CFP; 2212x1659px:
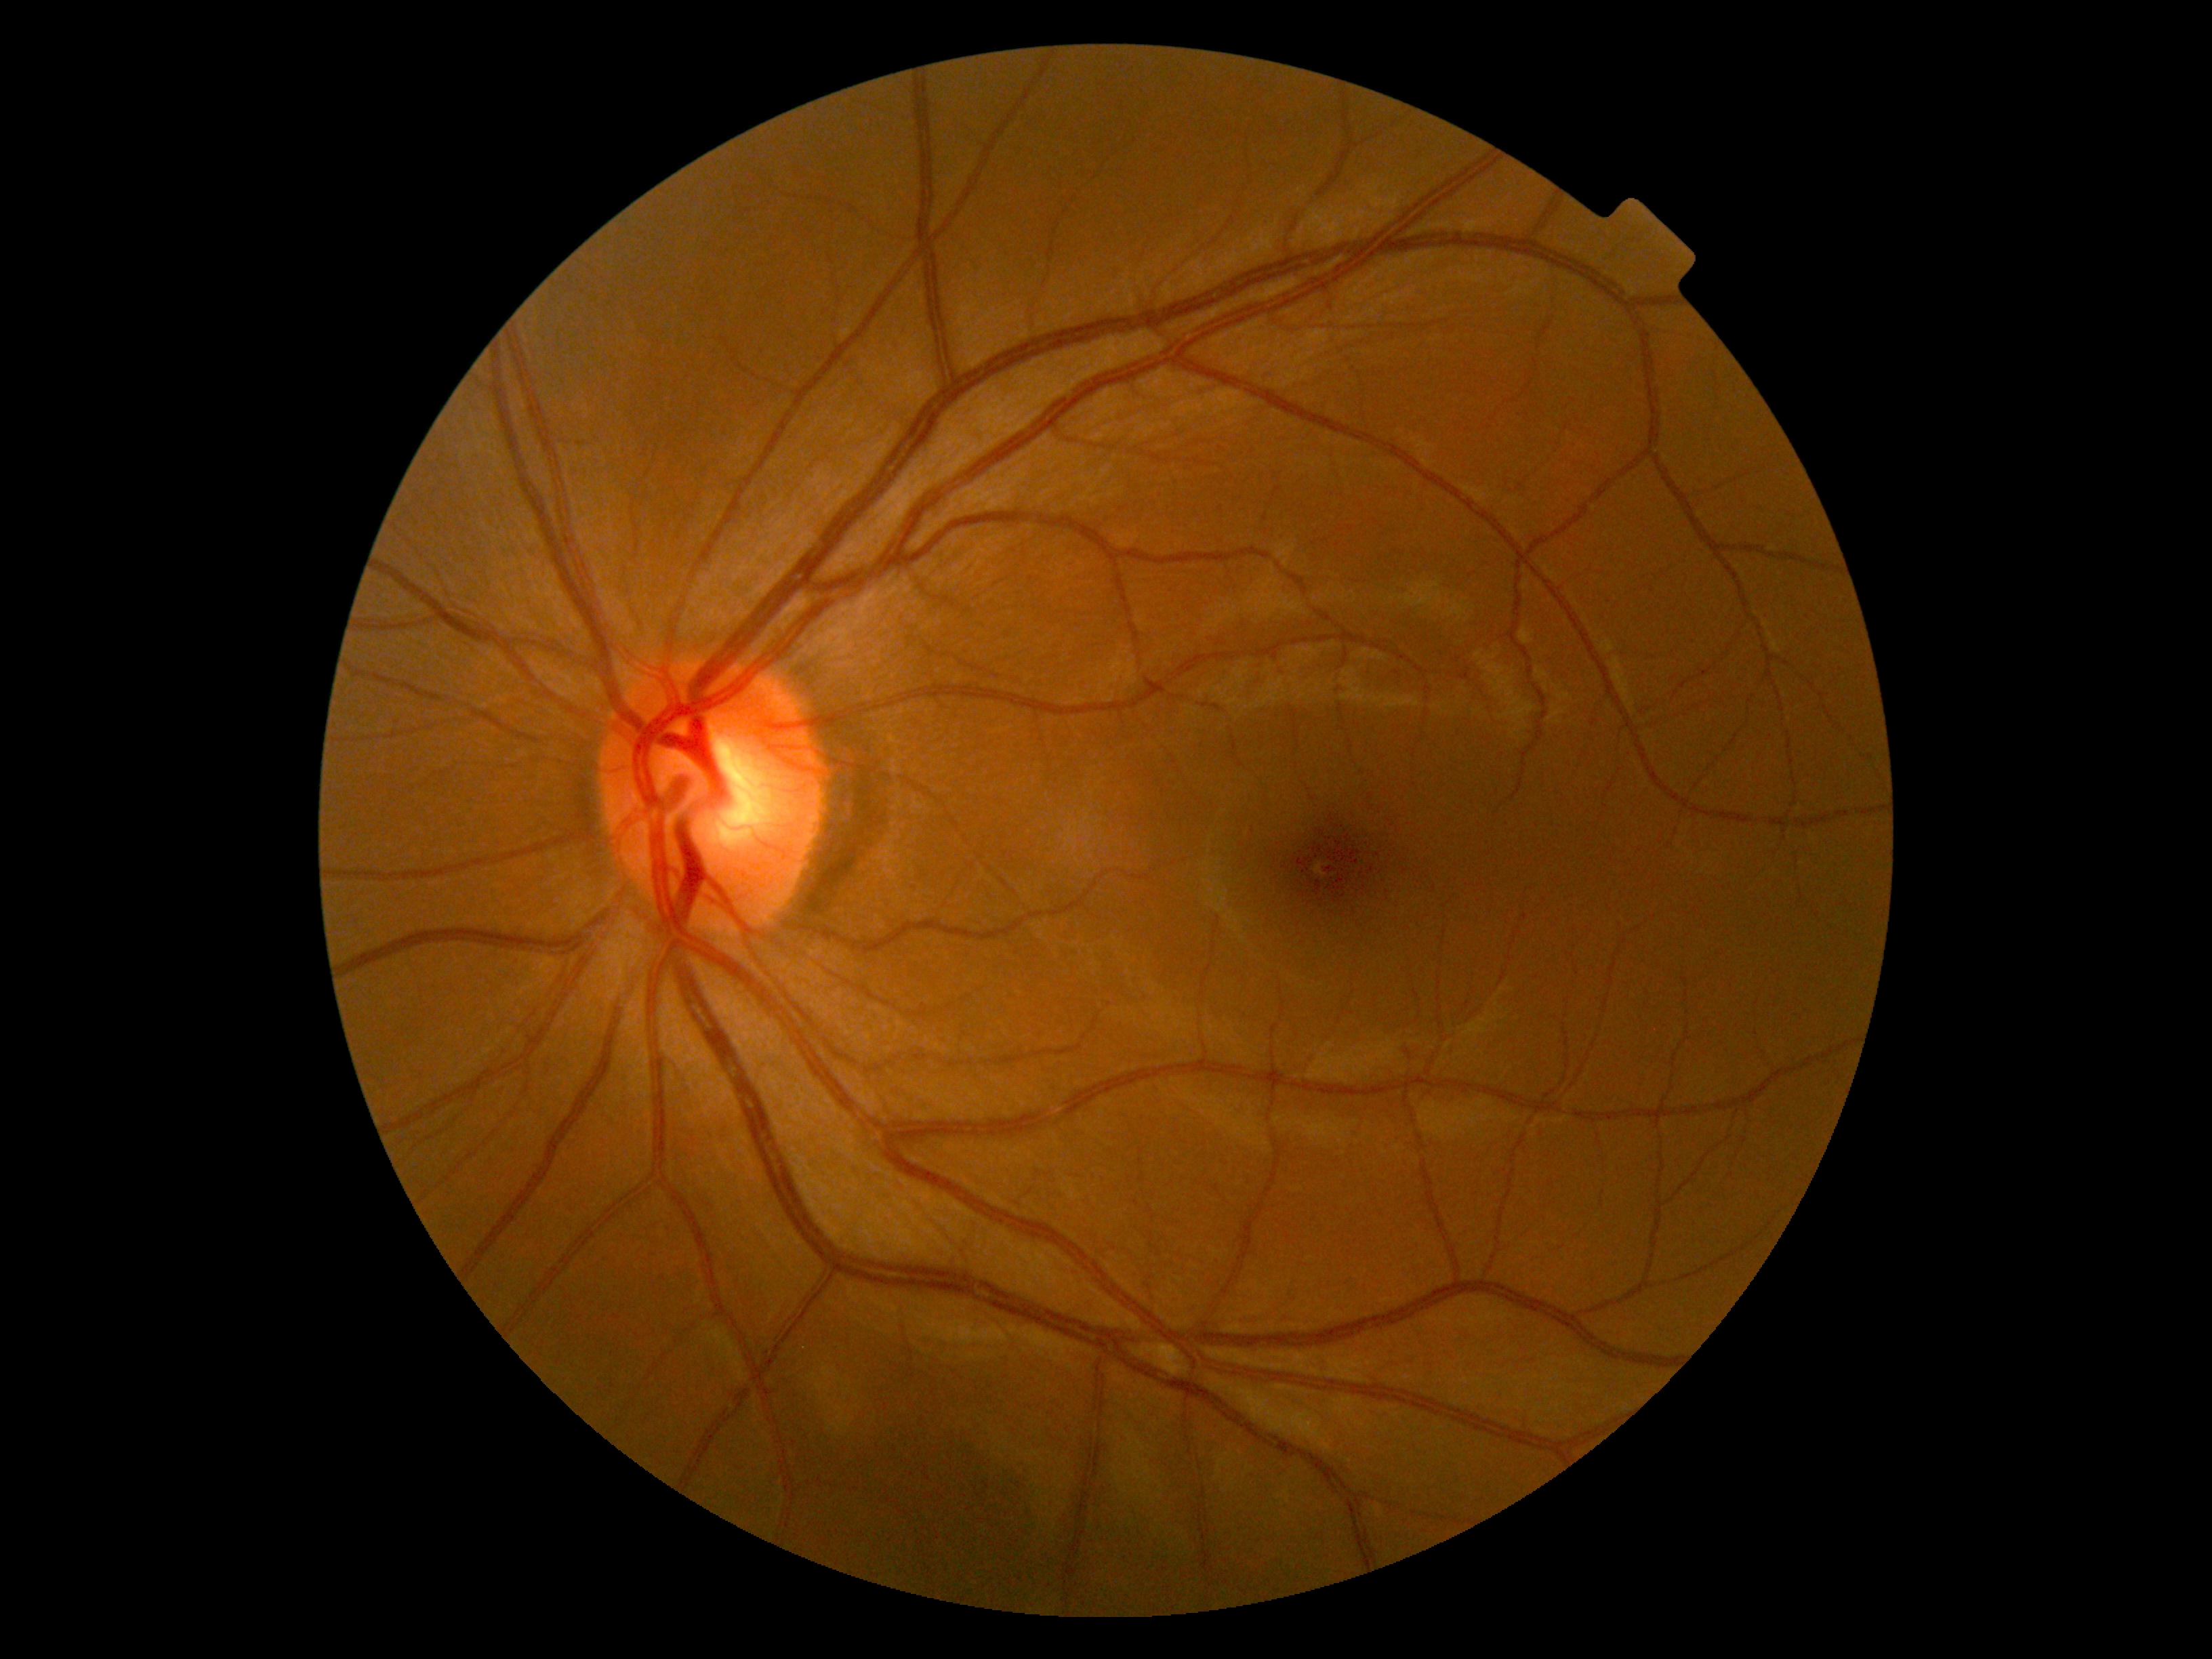

Diabetic retinopathy is grade 0 (no apparent retinopathy) — no visible signs of diabetic retinopathy.